2352x1568 · retinal fundus photograph: 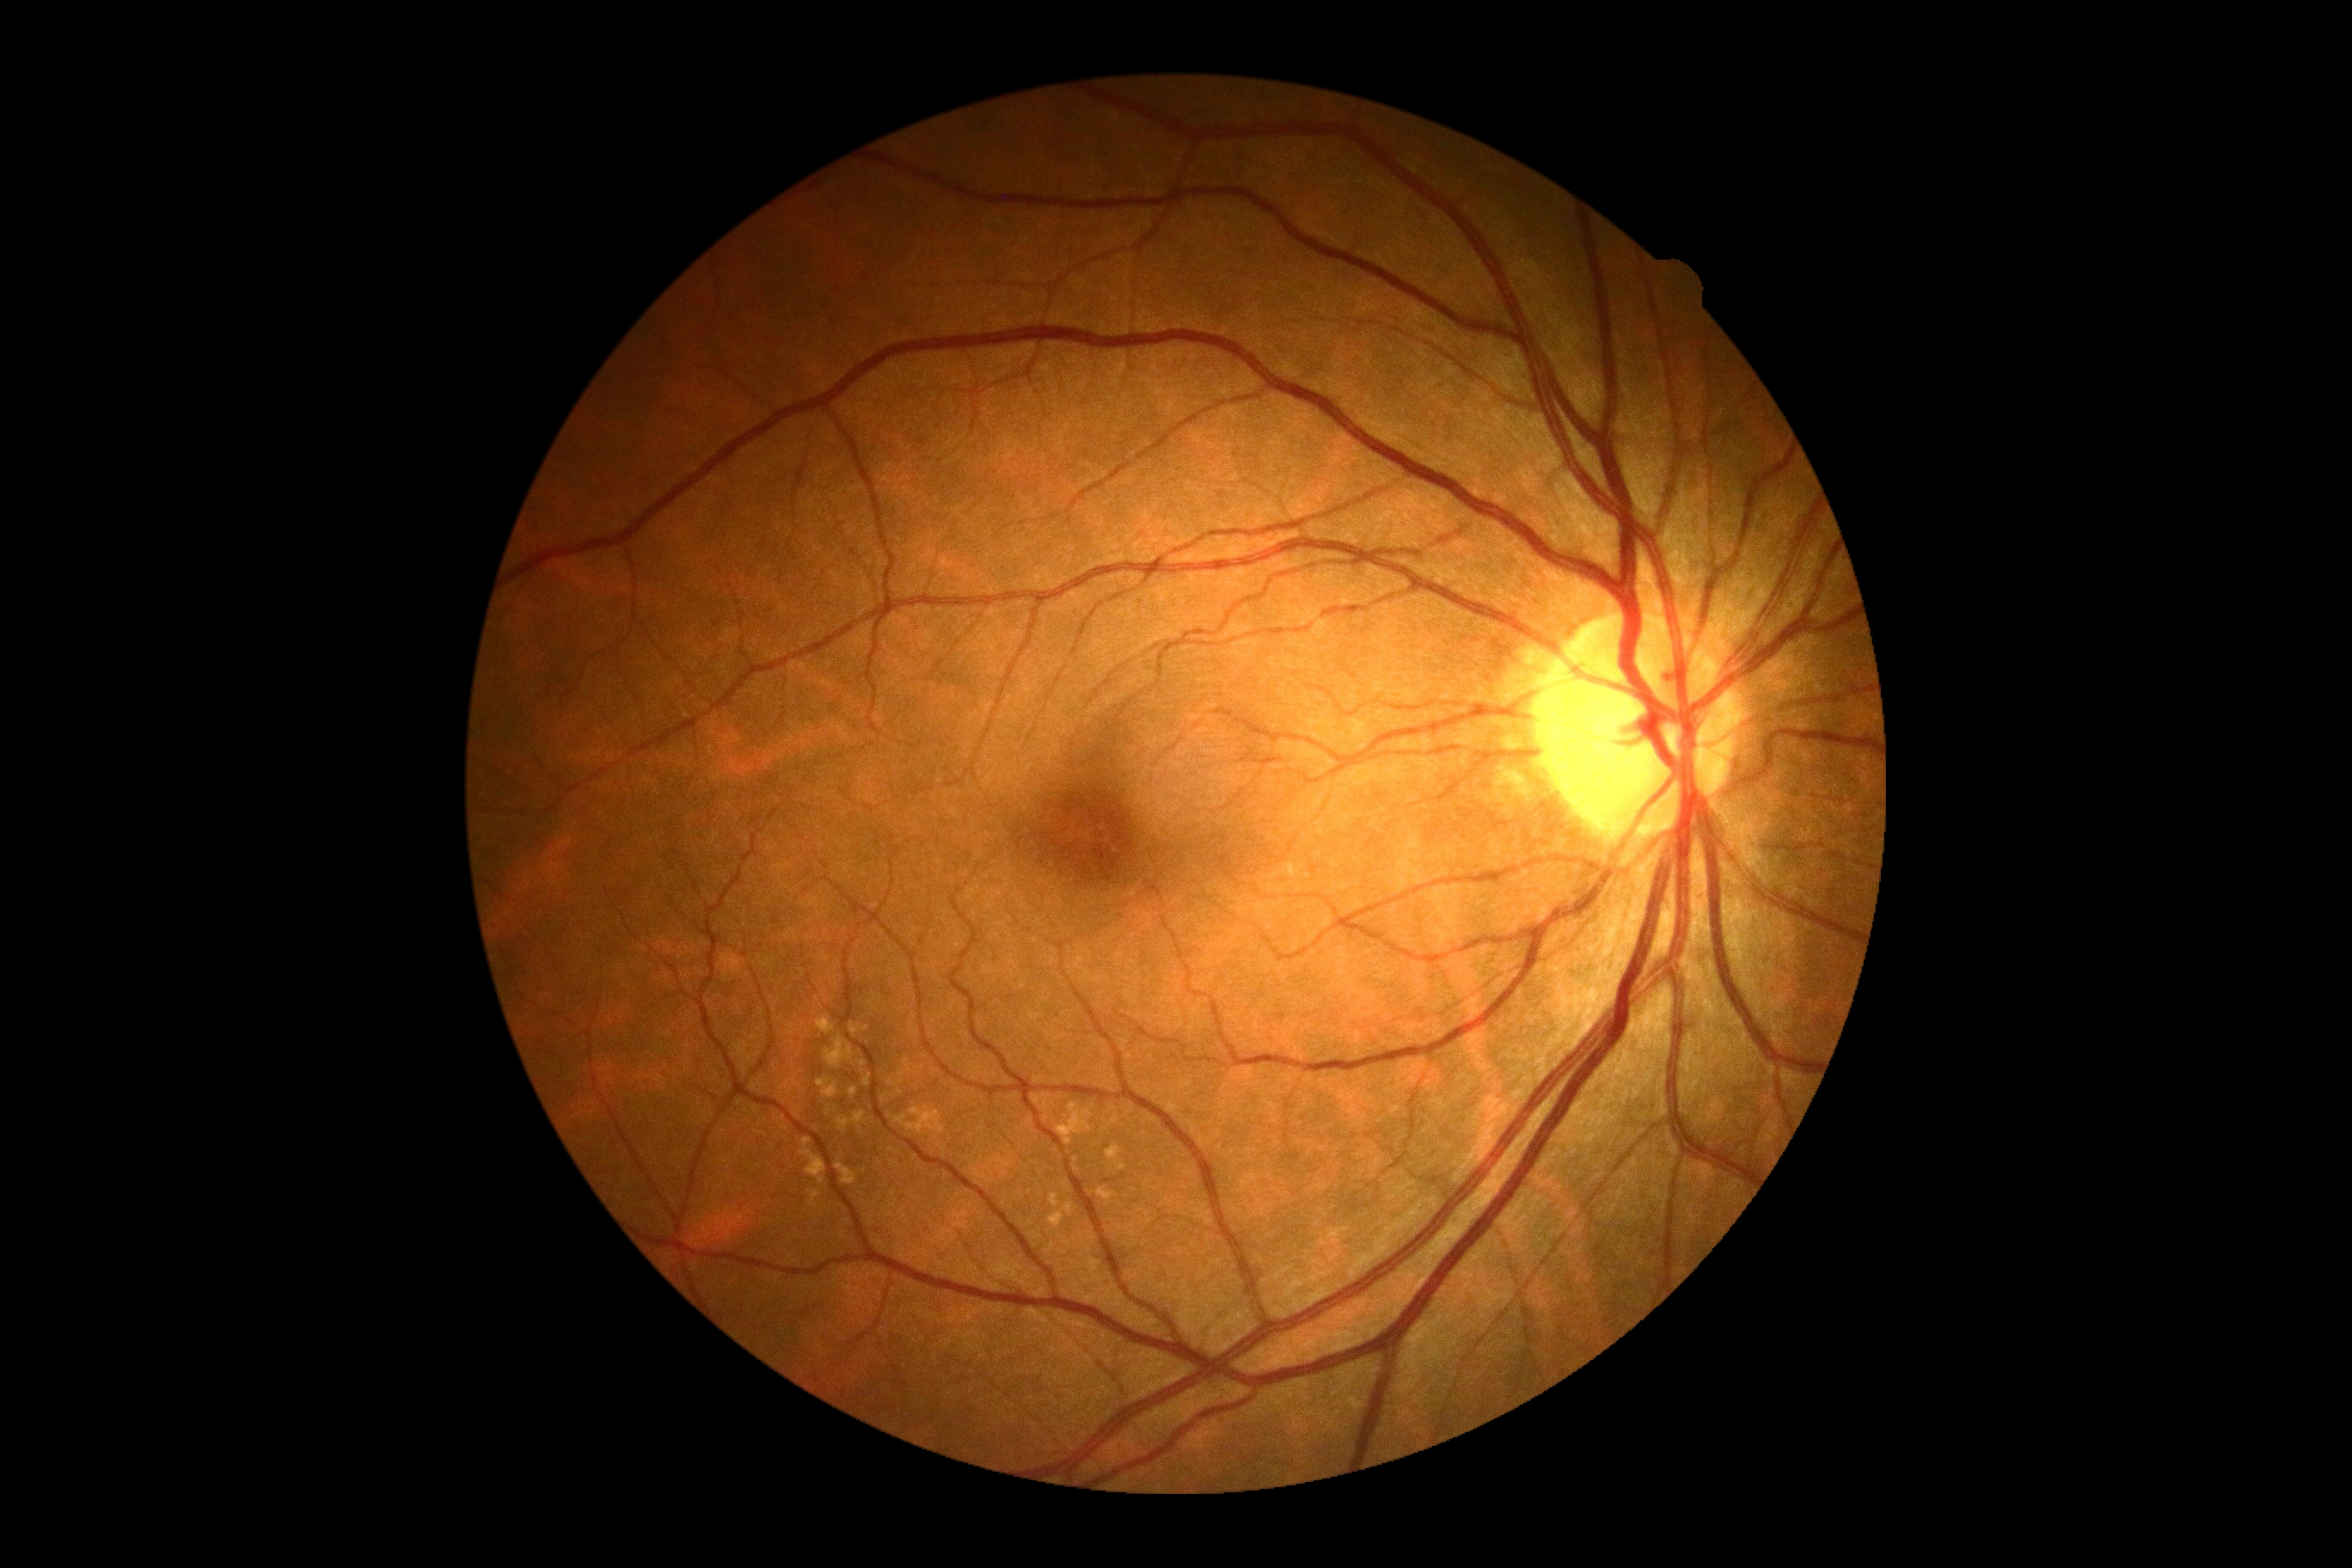 {"dr_impression": "no apparent DR", "dr_grade": "grade 0"}